Wide-field fundus photograph from neonatal ROP screening
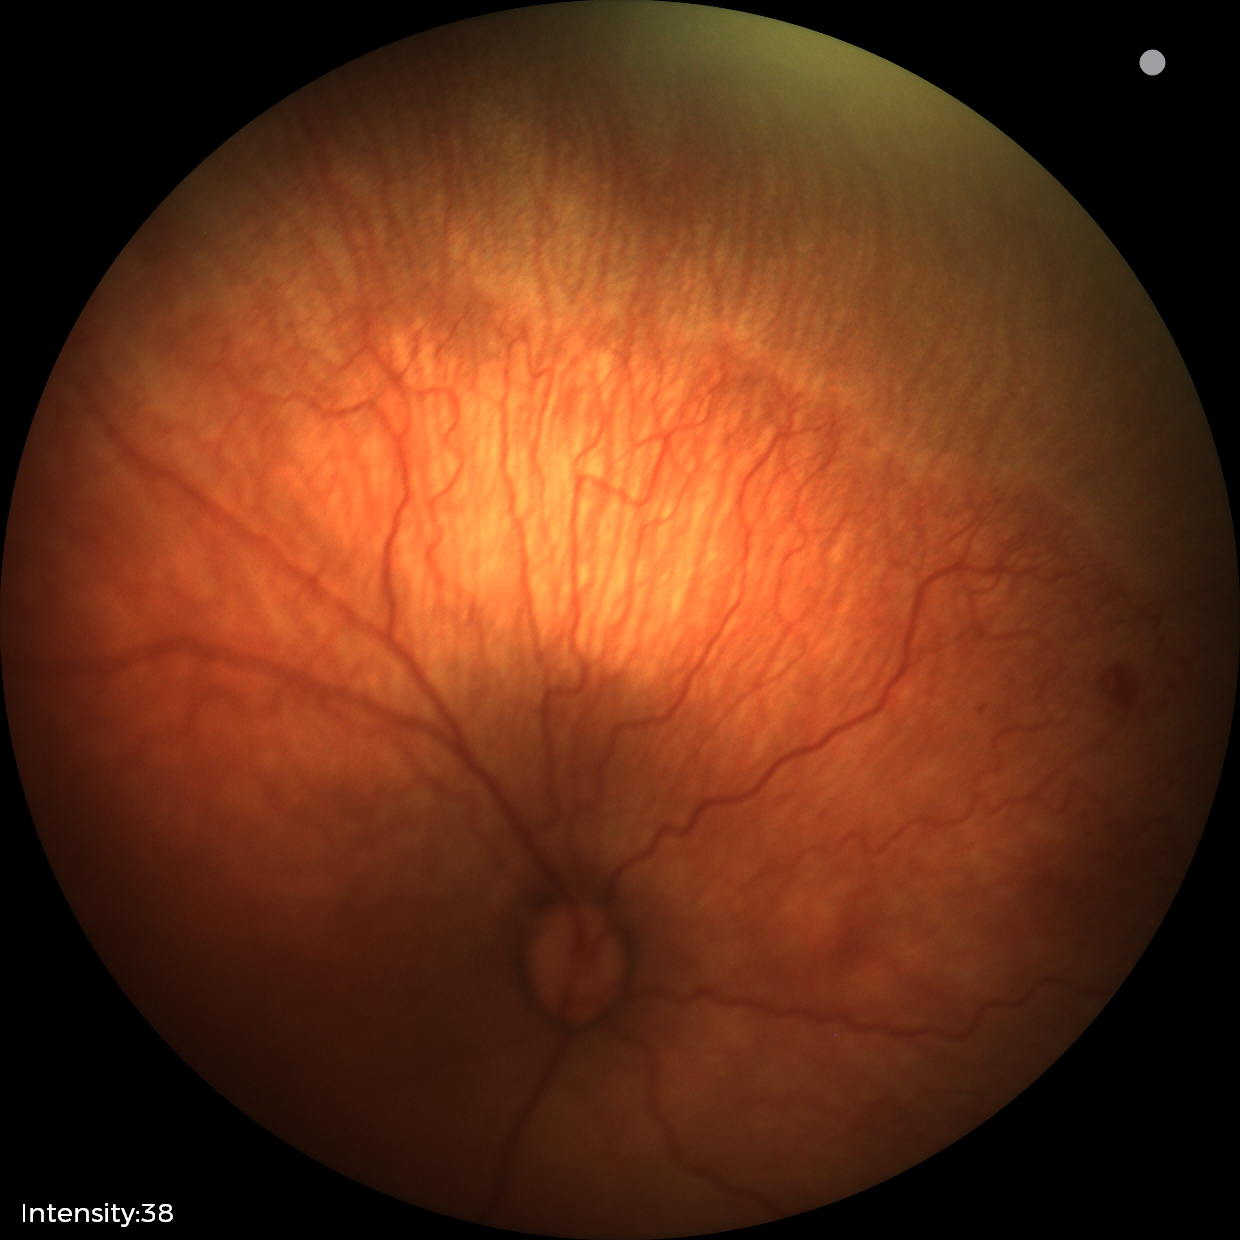
Plus disease absent. Series diagnosed as retinopathy of prematurity stage 1.